Wide-field contact fundus photograph of an infant; 640x480px; captured with the Clarity RetCam 3 (130° field of view) — 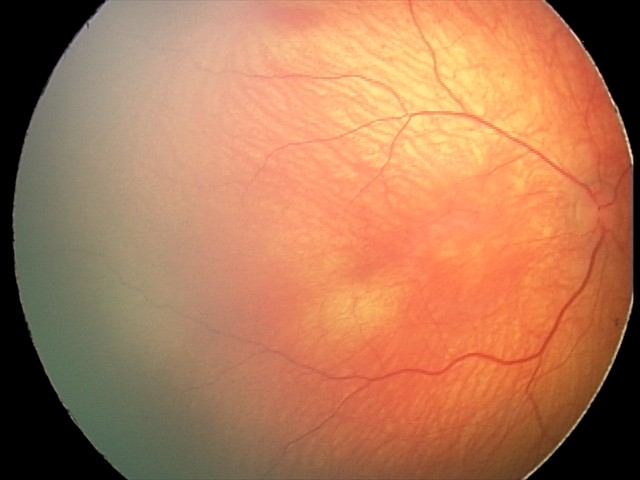 Q: What is the diagnosis from this examination?
A: normal retinal appearance